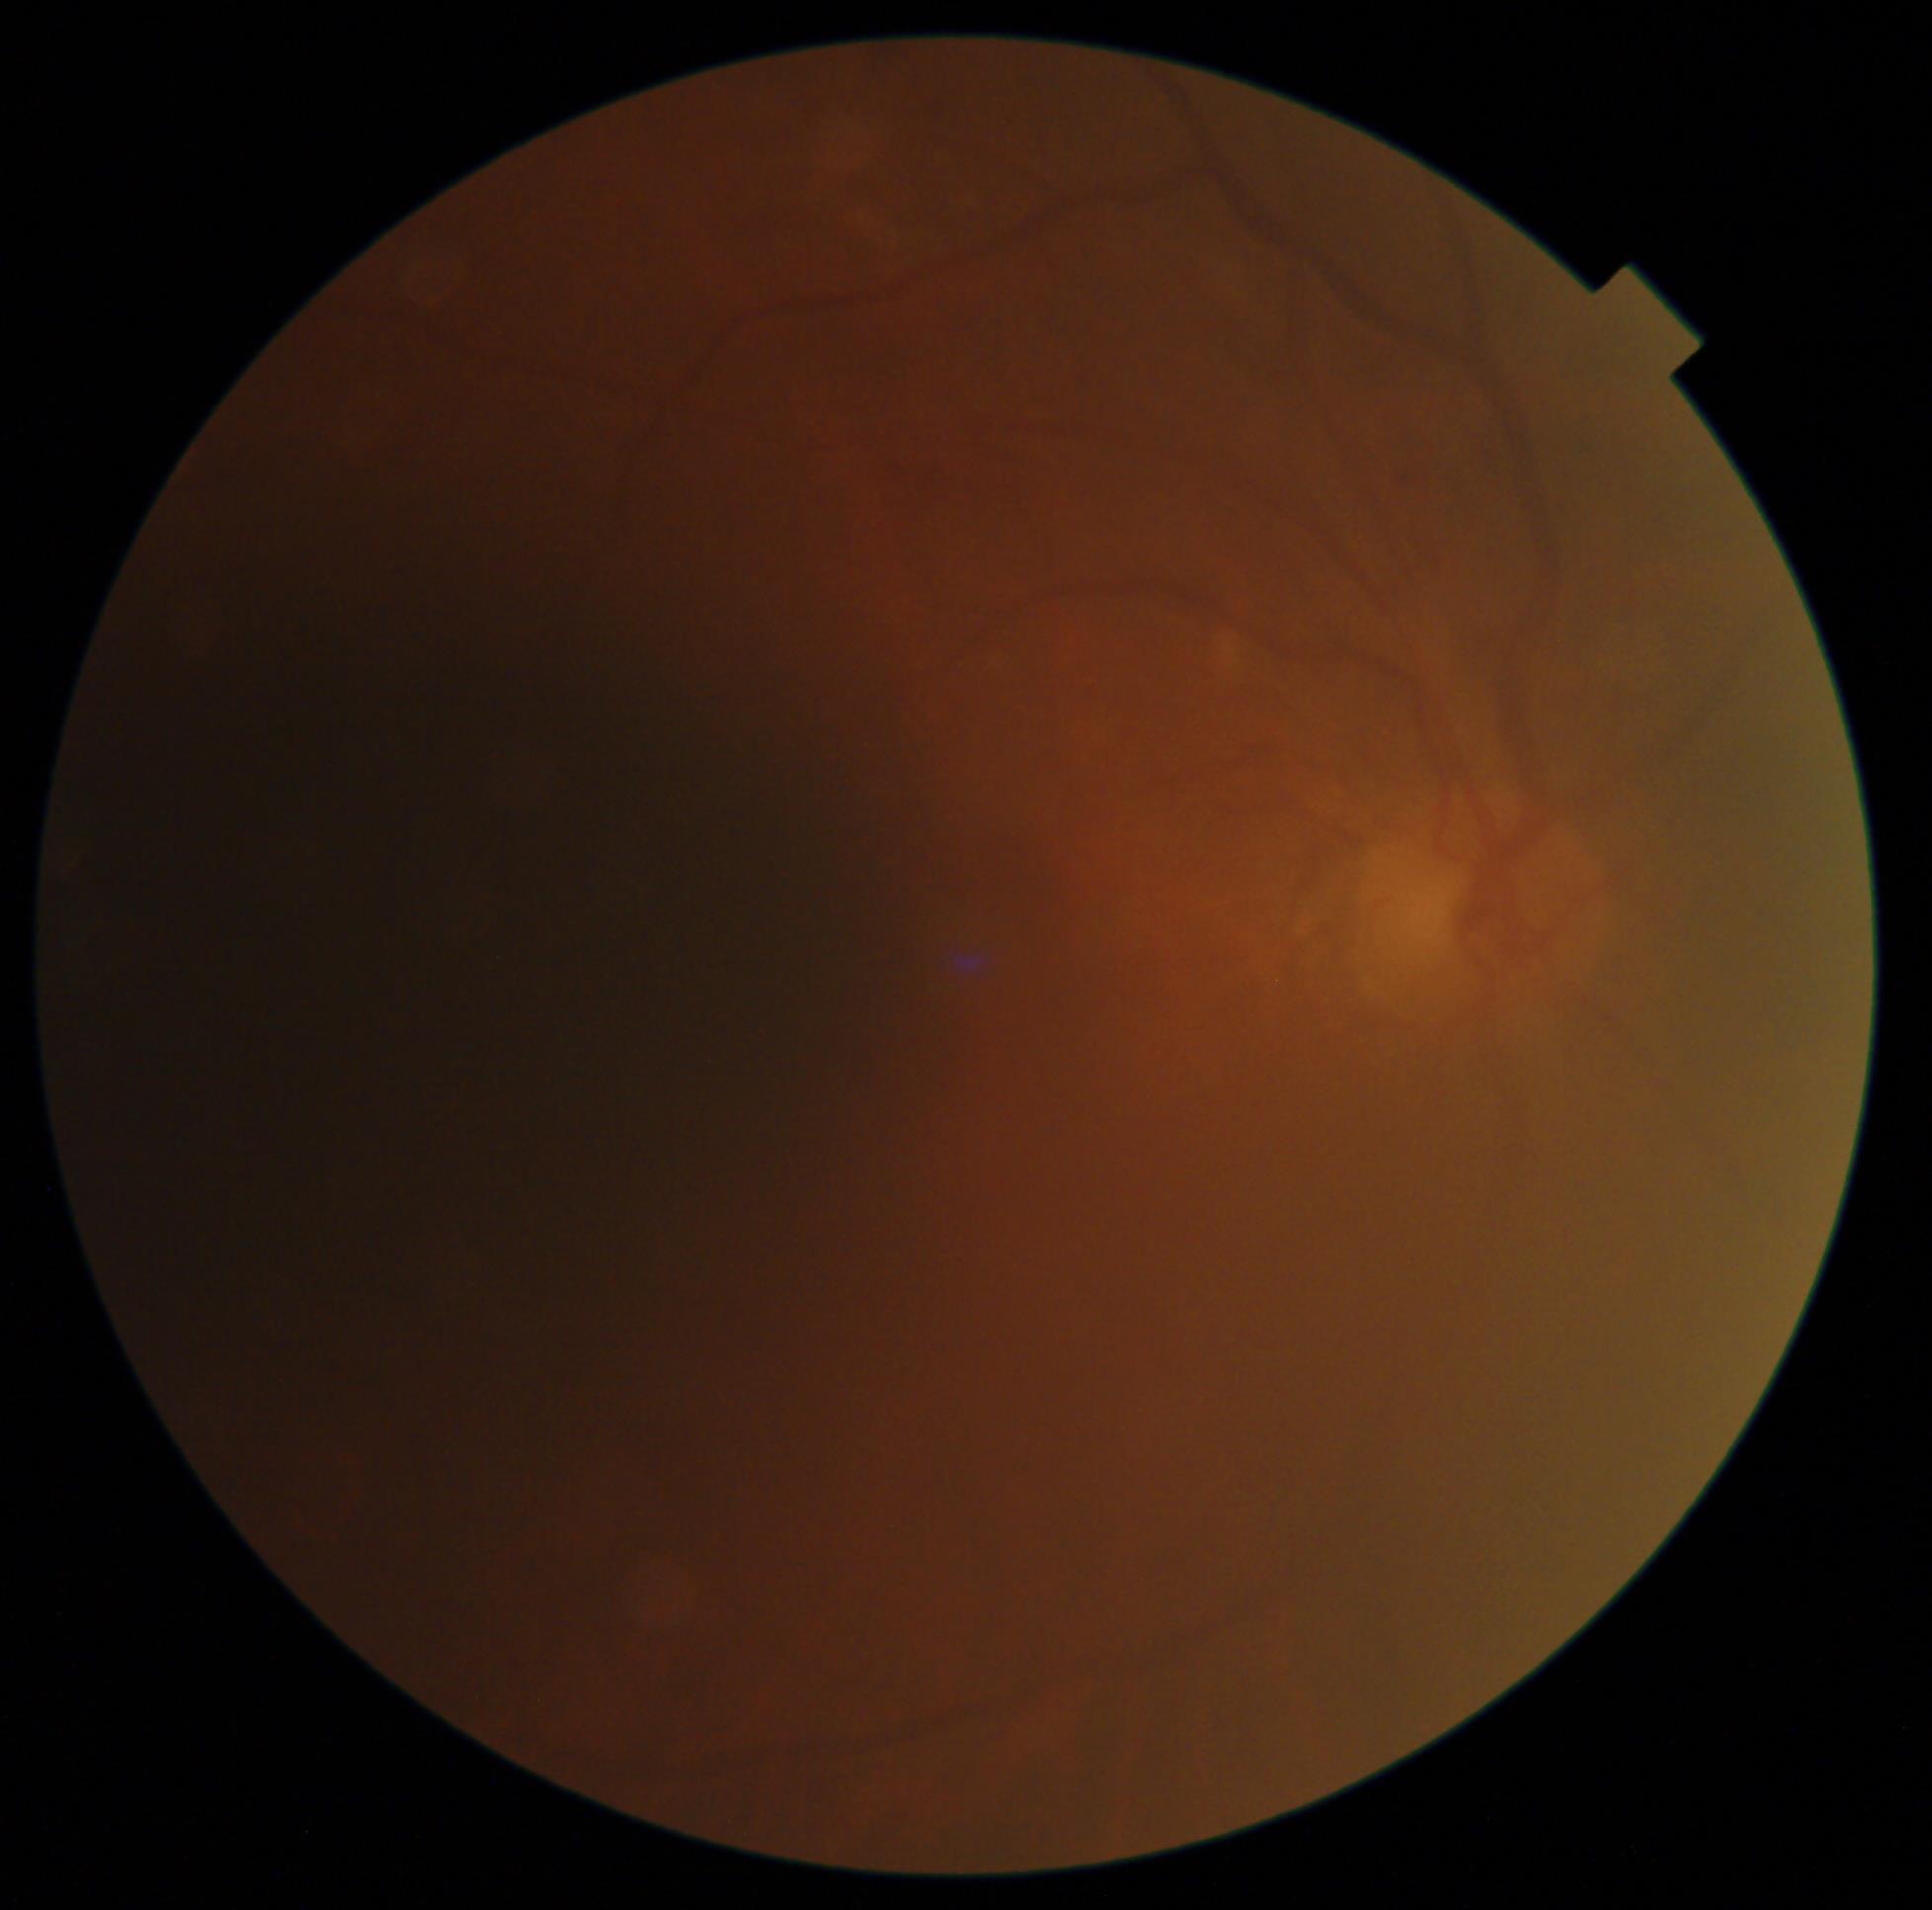

Ungradable image — DR severity cannot be determined. Diabetic retinopathy (DR): ungradable due to poor image quality.